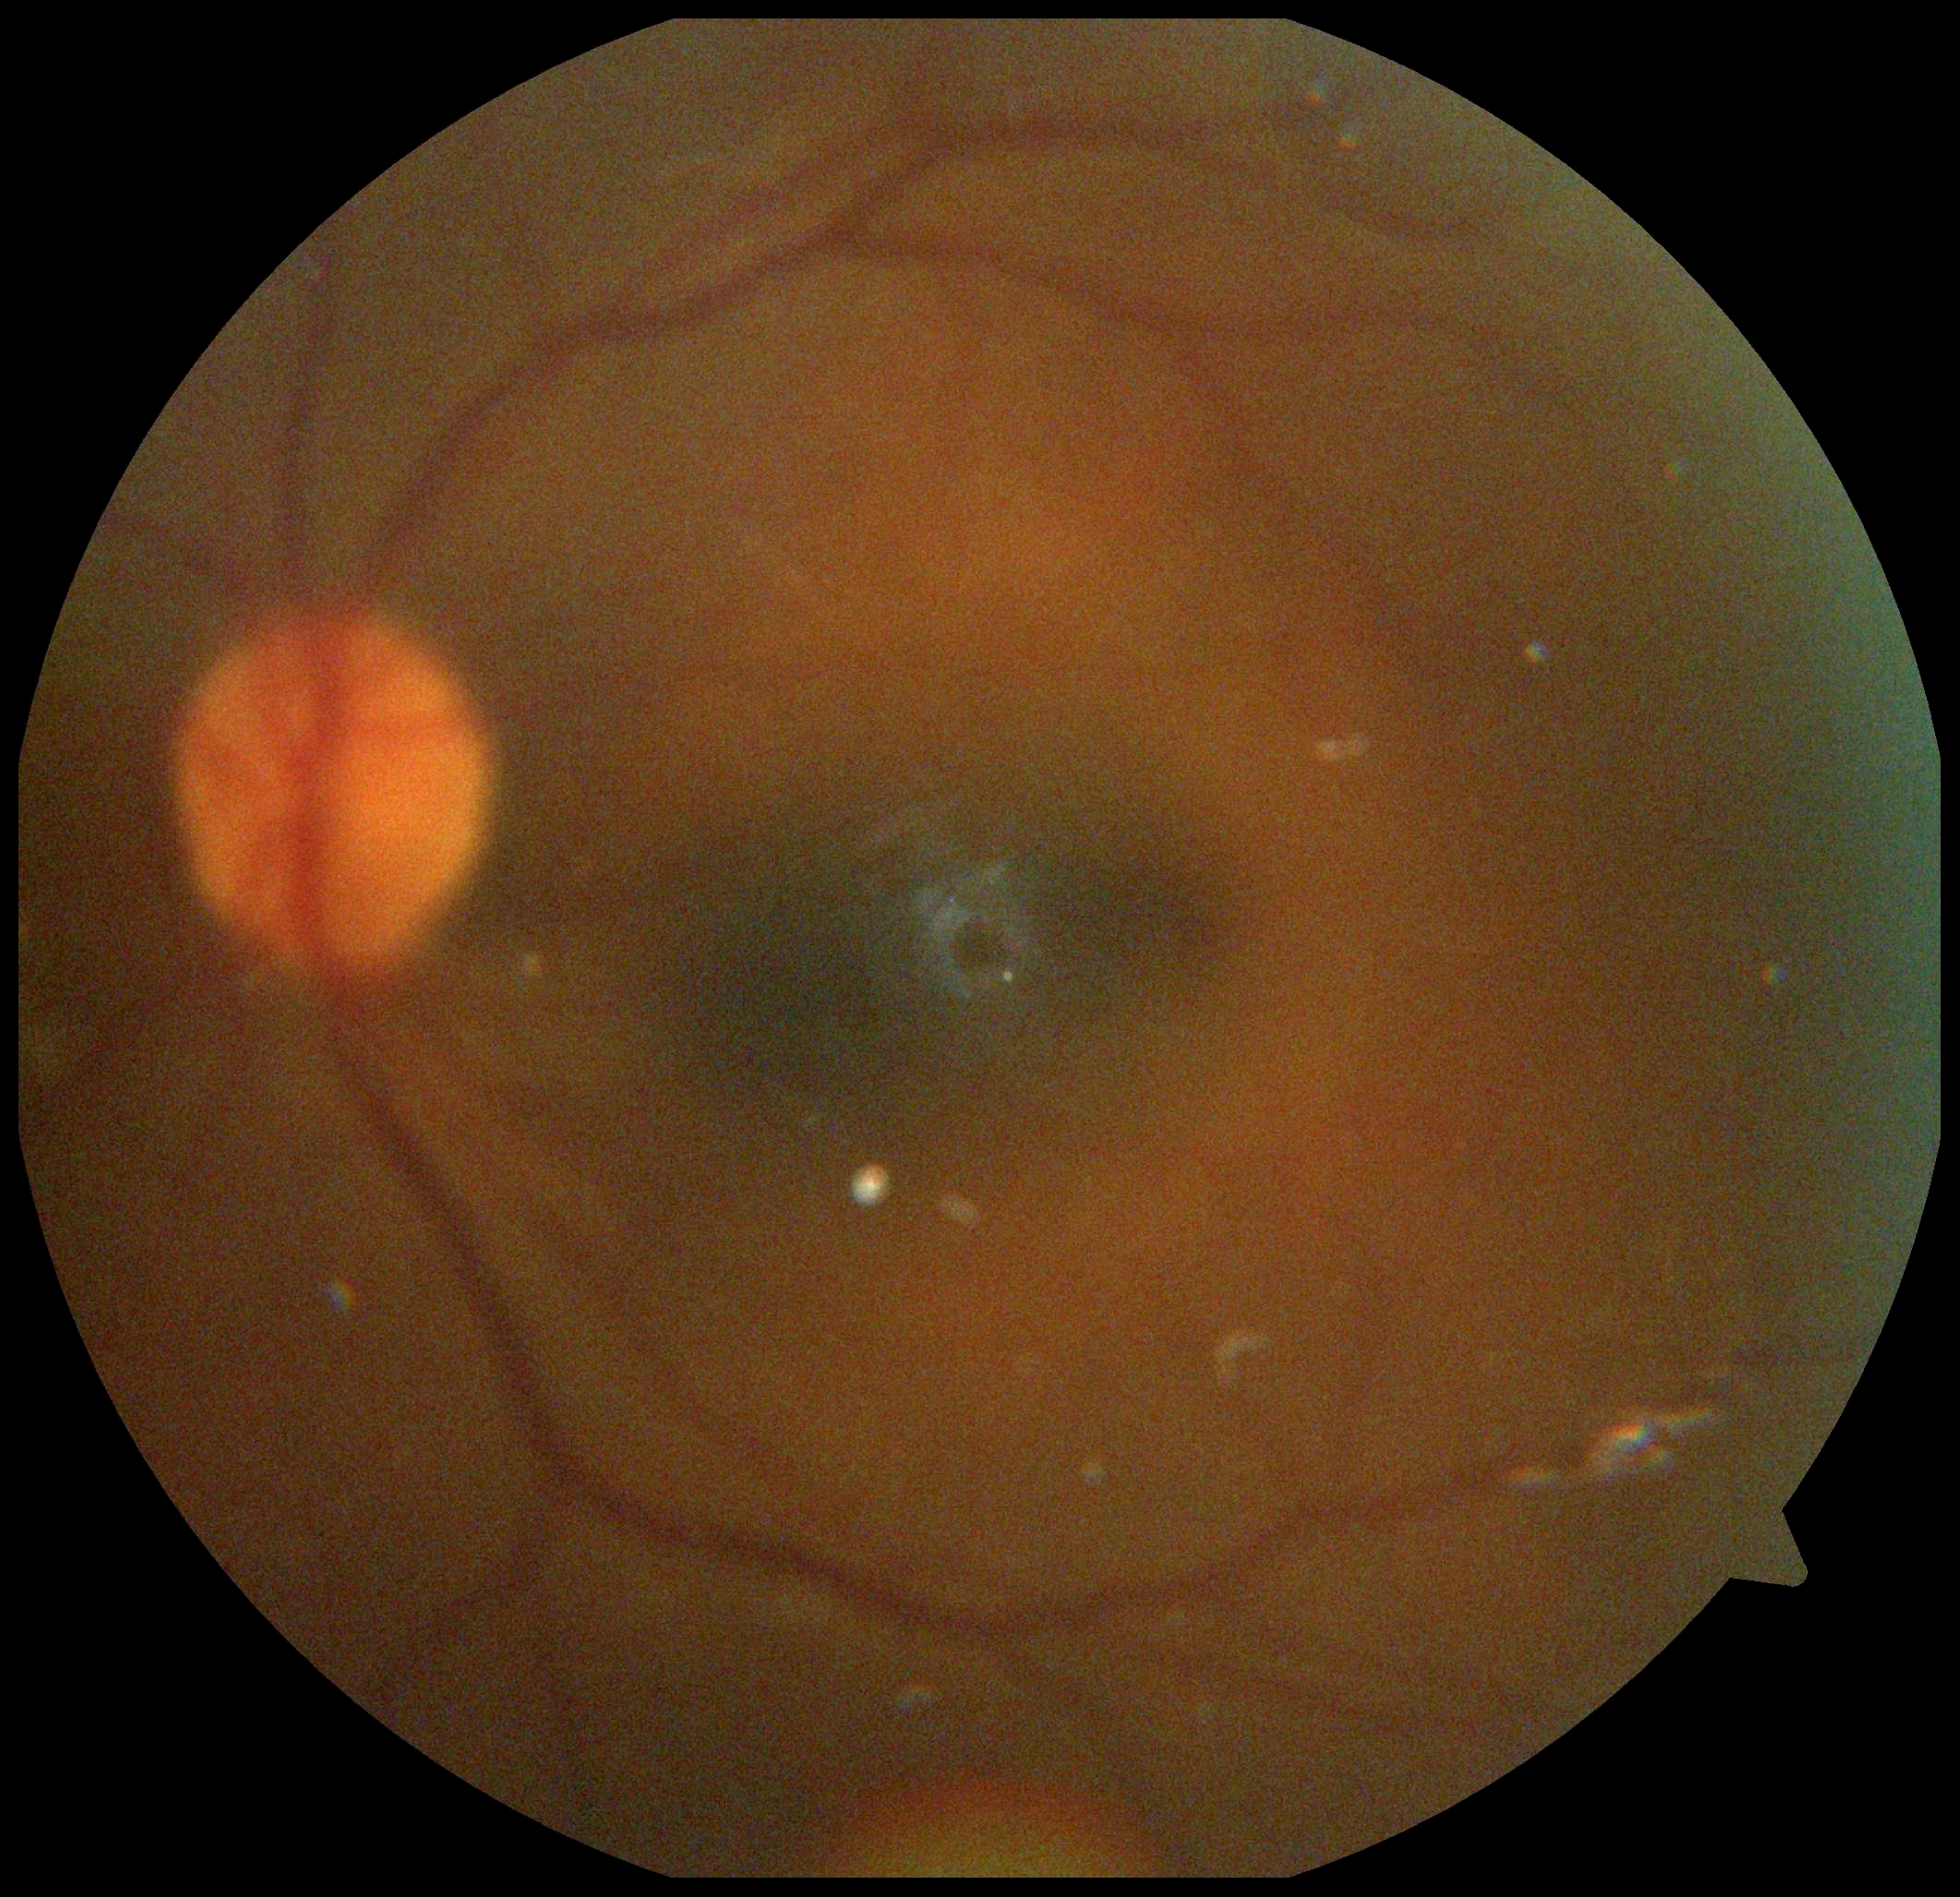

Diabetic retinopathy (DR): grade 0 (no apparent retinopathy) — no visible signs of diabetic retinopathy.